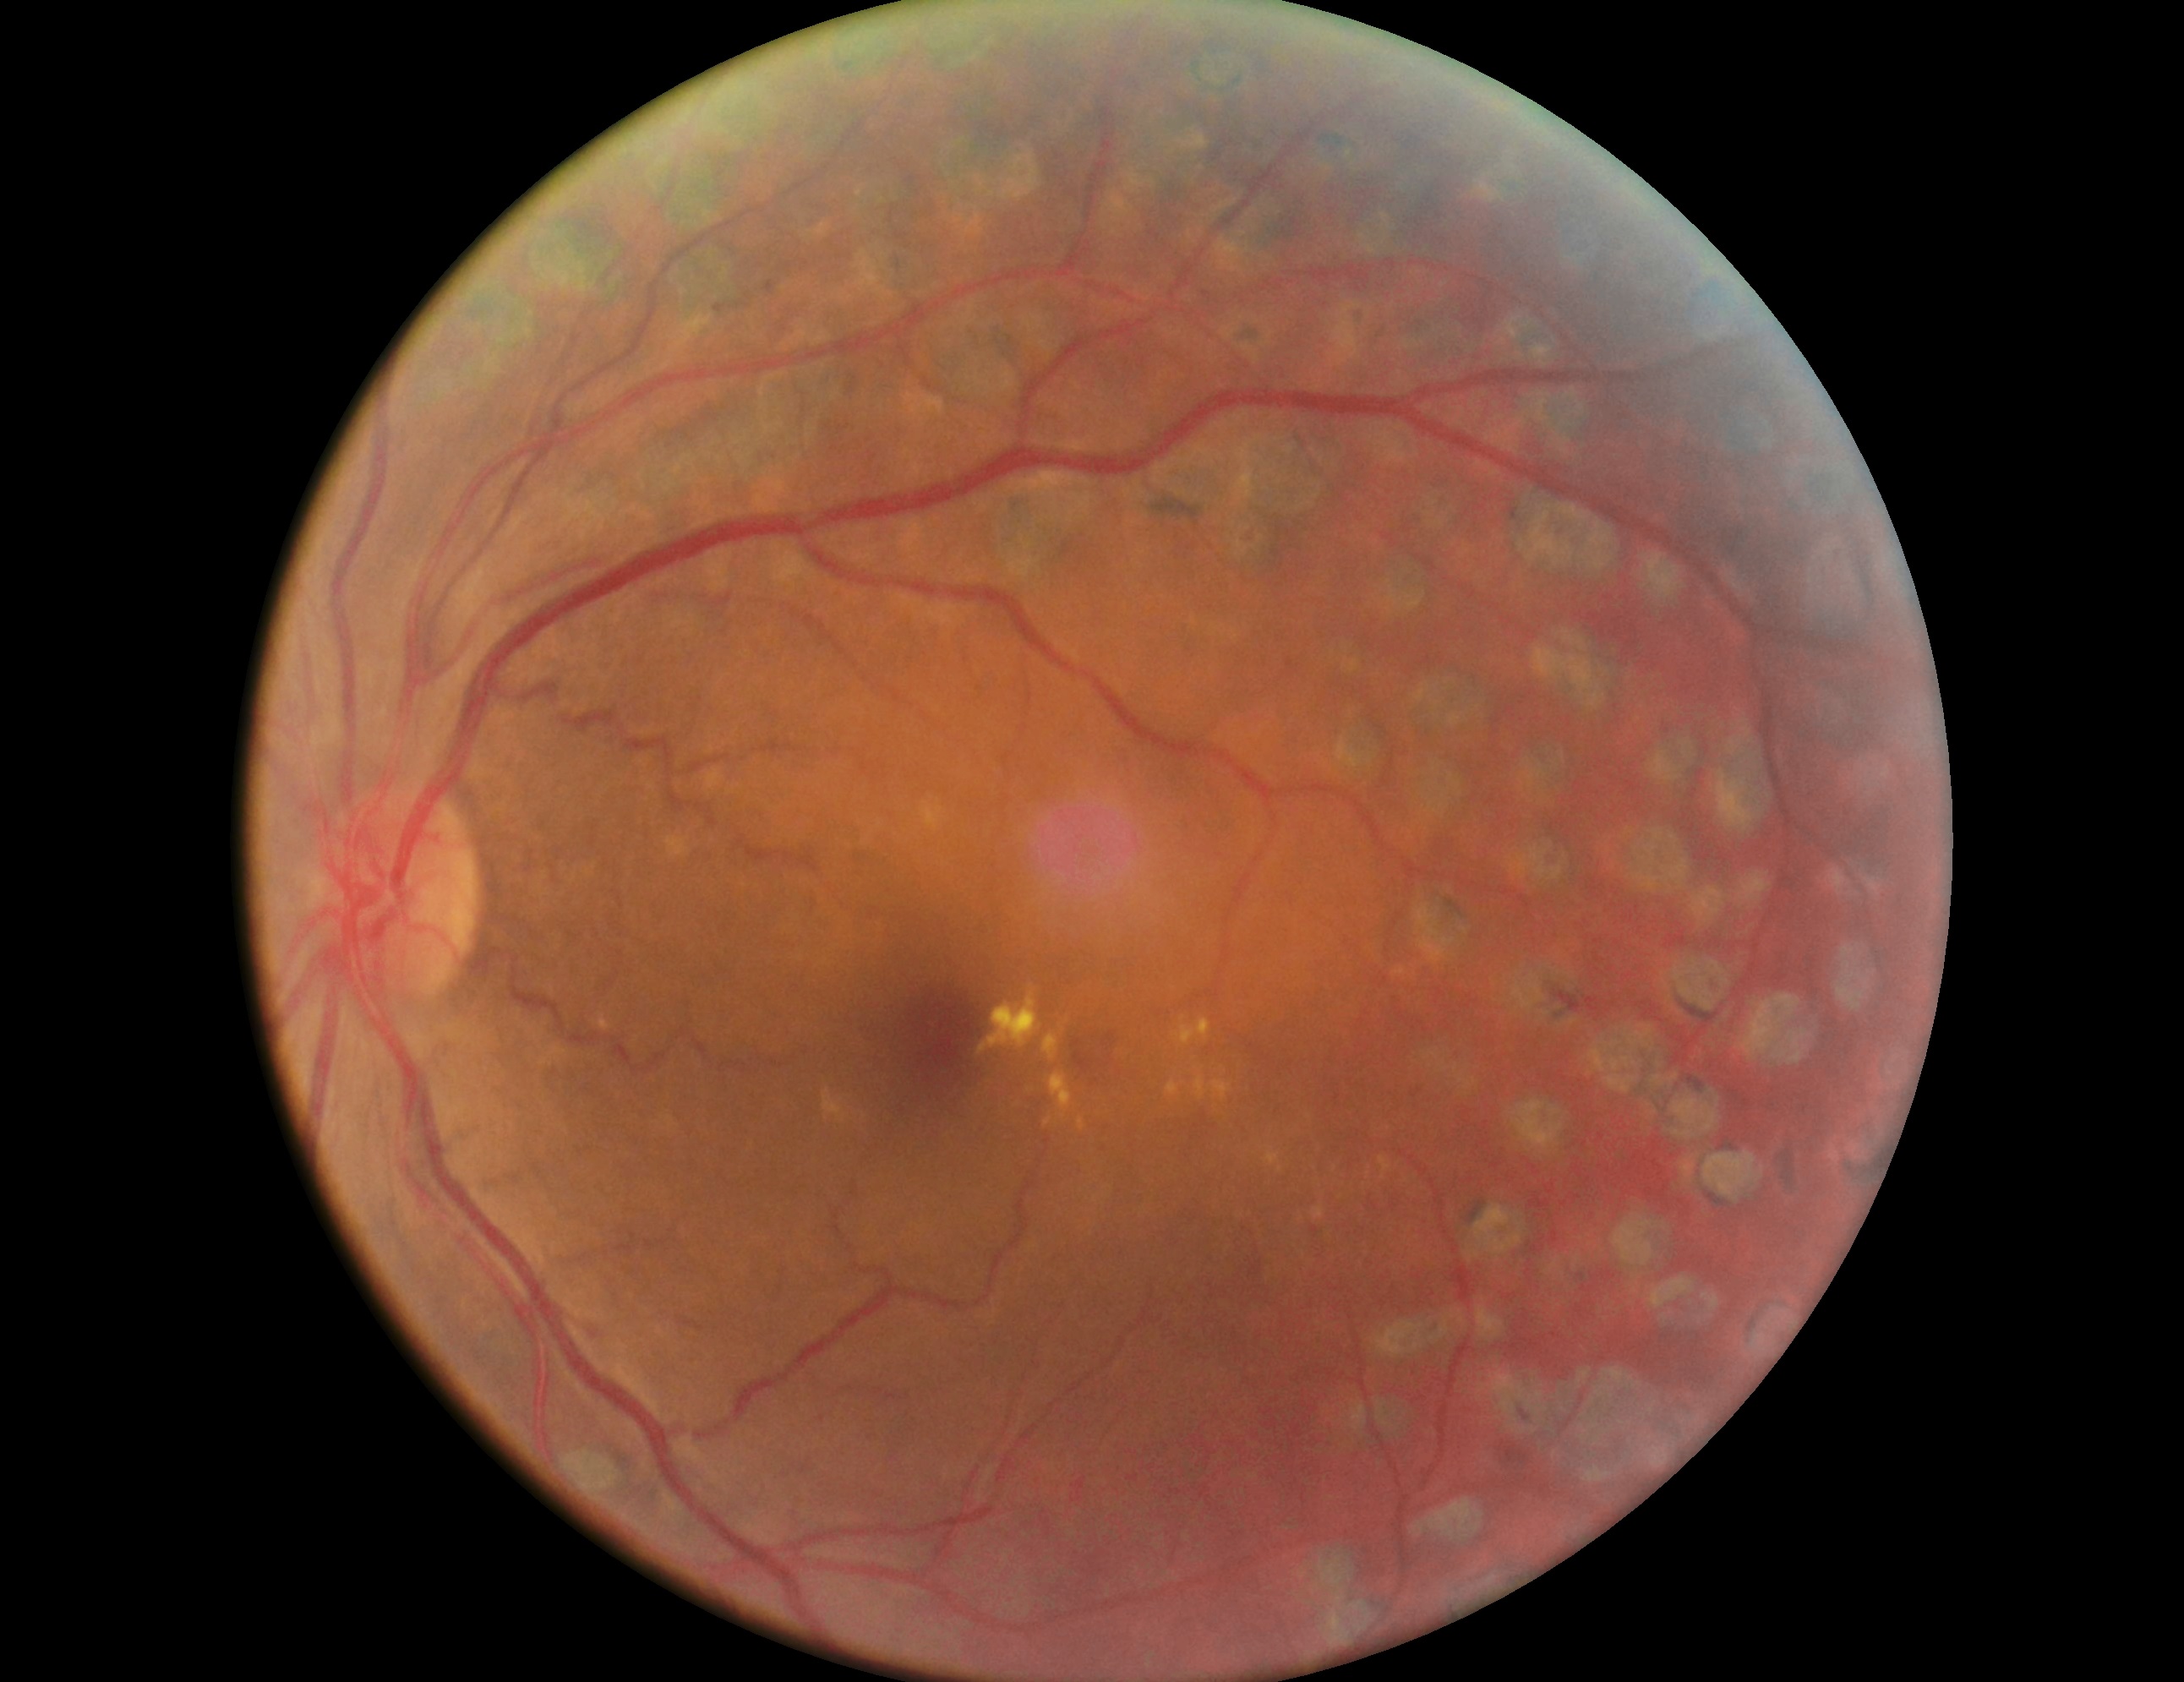 DR: grade 2 (moderate NPDR).